Pediatric wide-field fundus photograph · image size 640x480 · acquired on the Clarity RetCam 3:
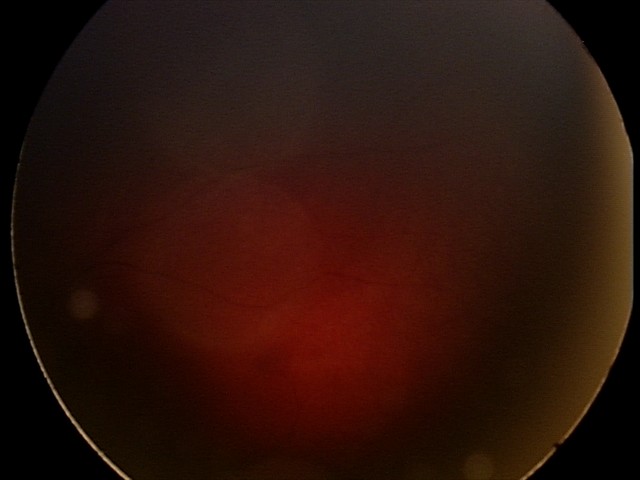 Diagnosis from this screening exam: retinal hemorrhages.